512x512px.
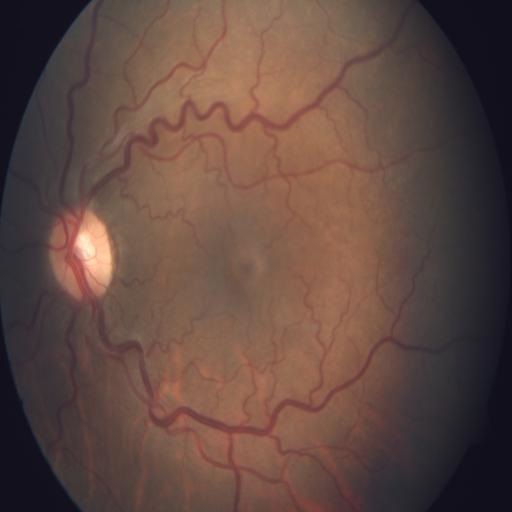

Showing tortuous vessels.